Color fundus image · 45° field of view: 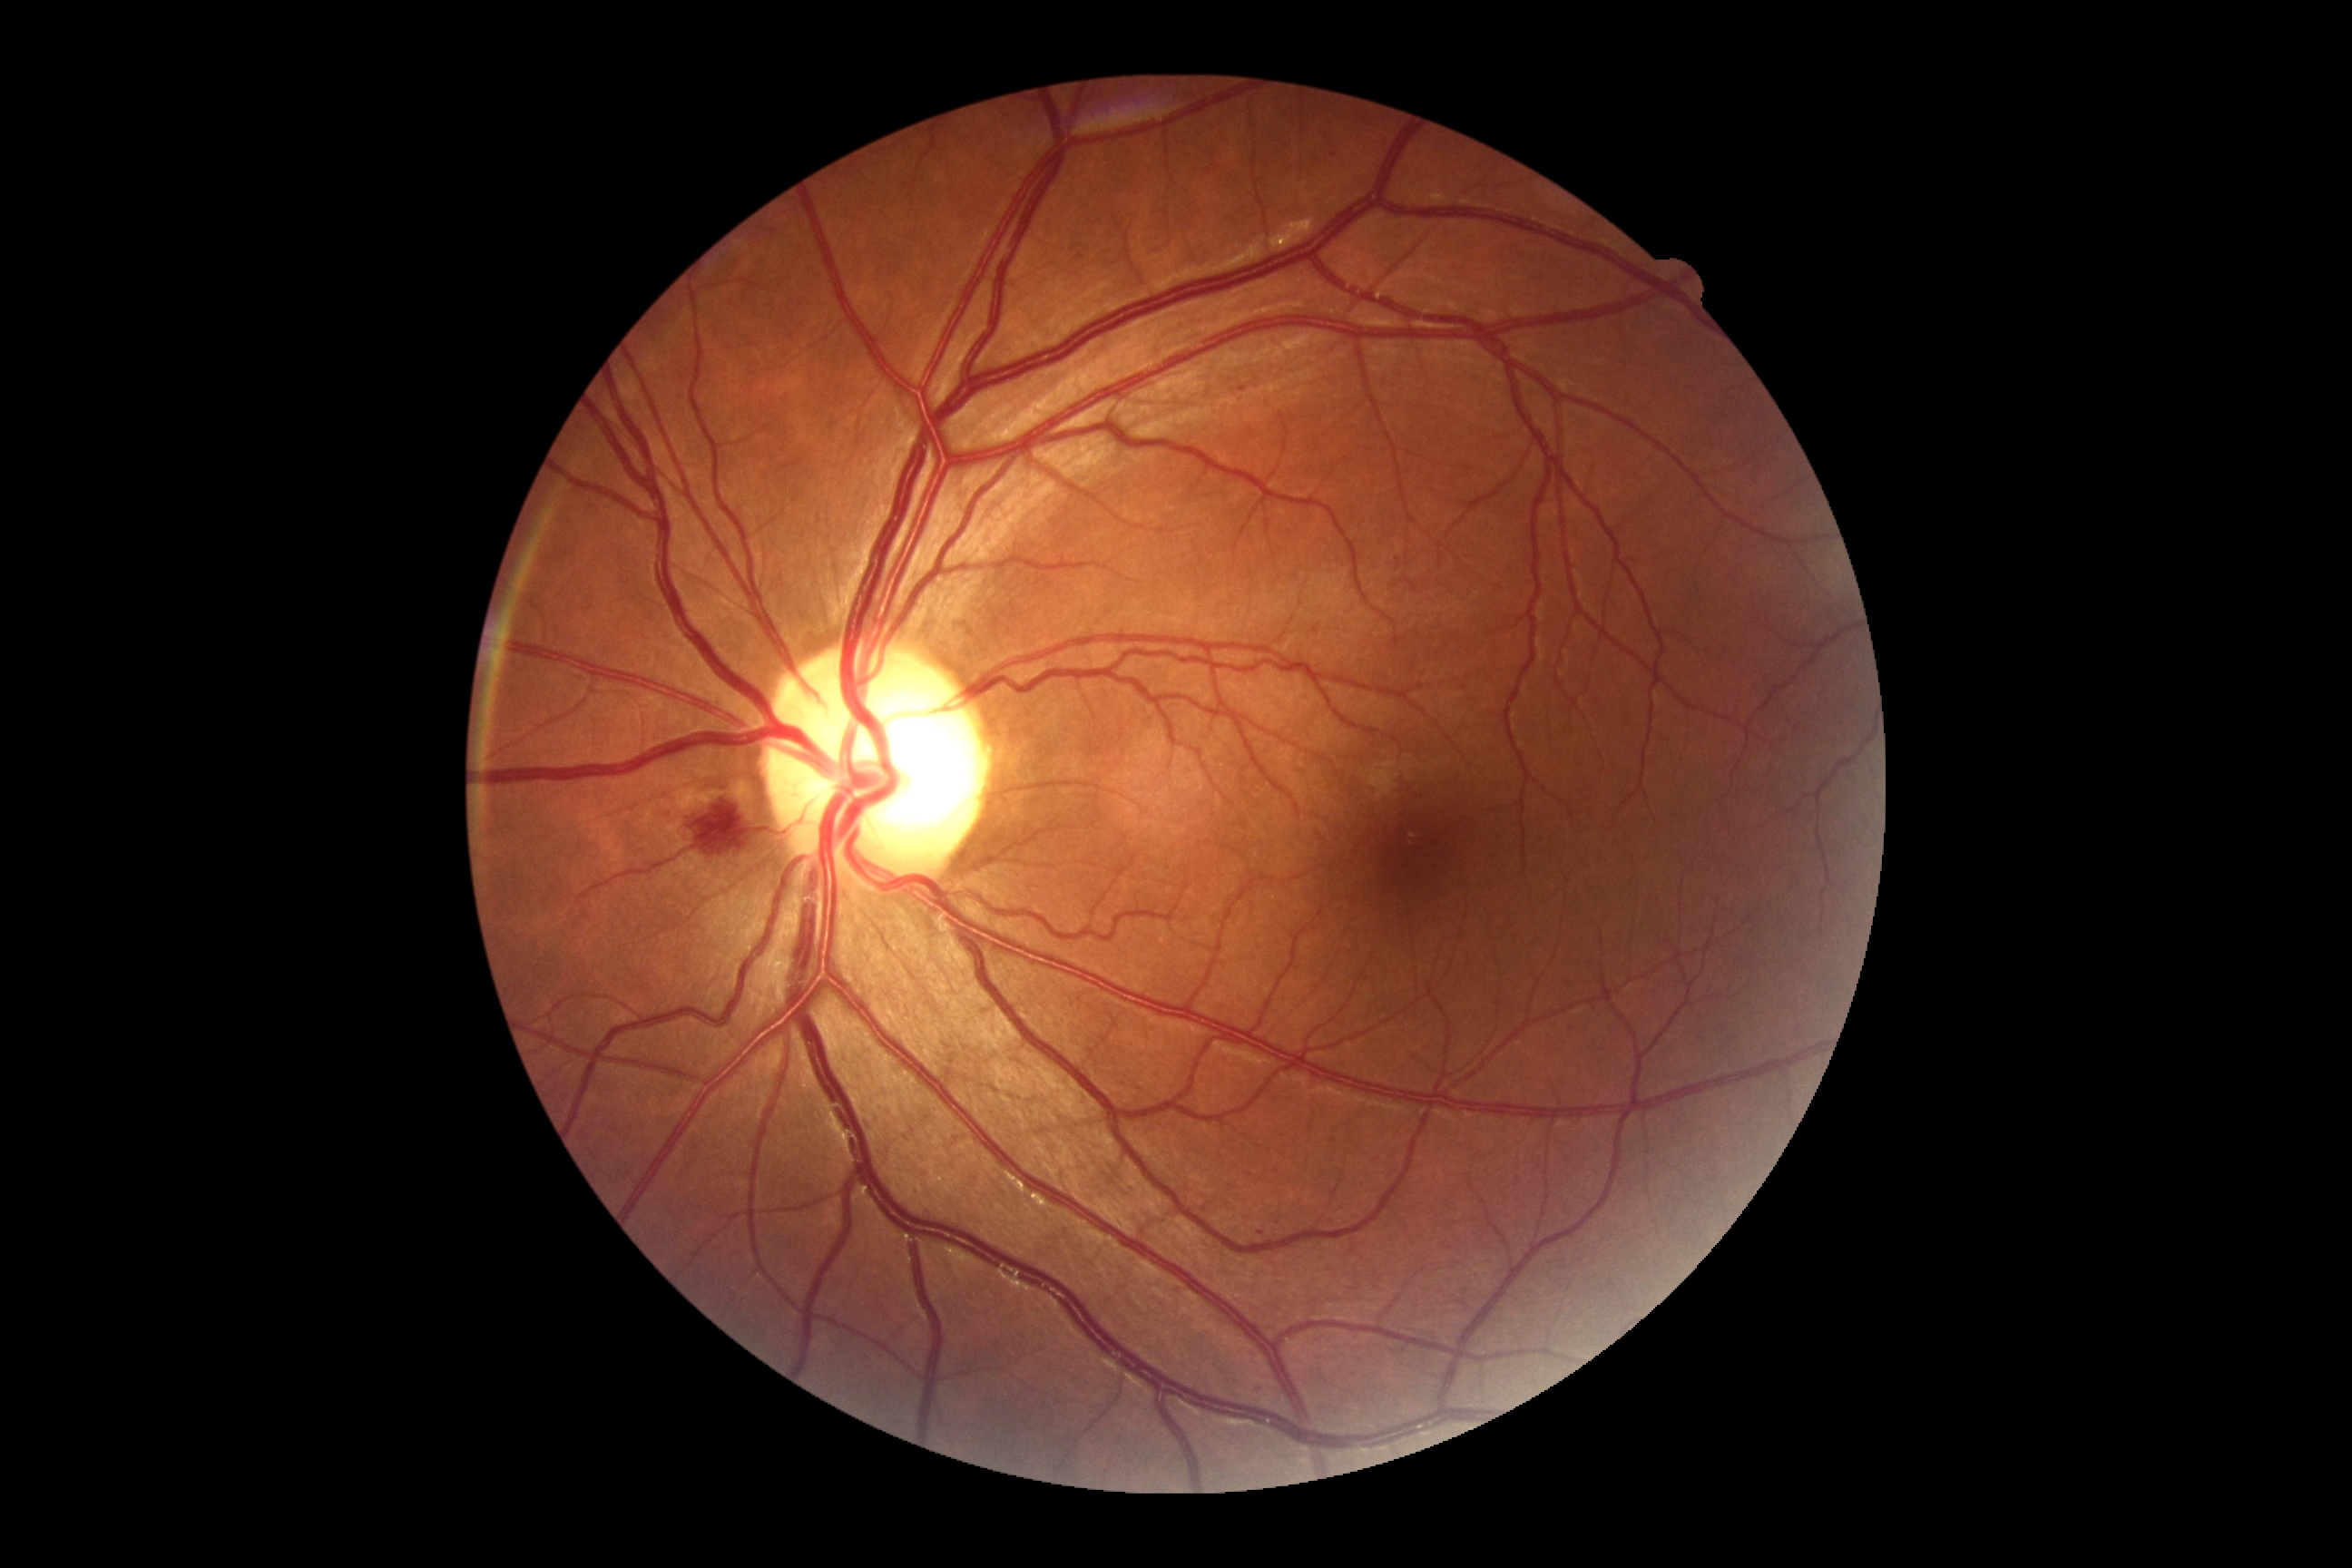 Findings:
* DR: moderate NPDR (grade 2)